45° field of view · 2352x1568px · CFP.
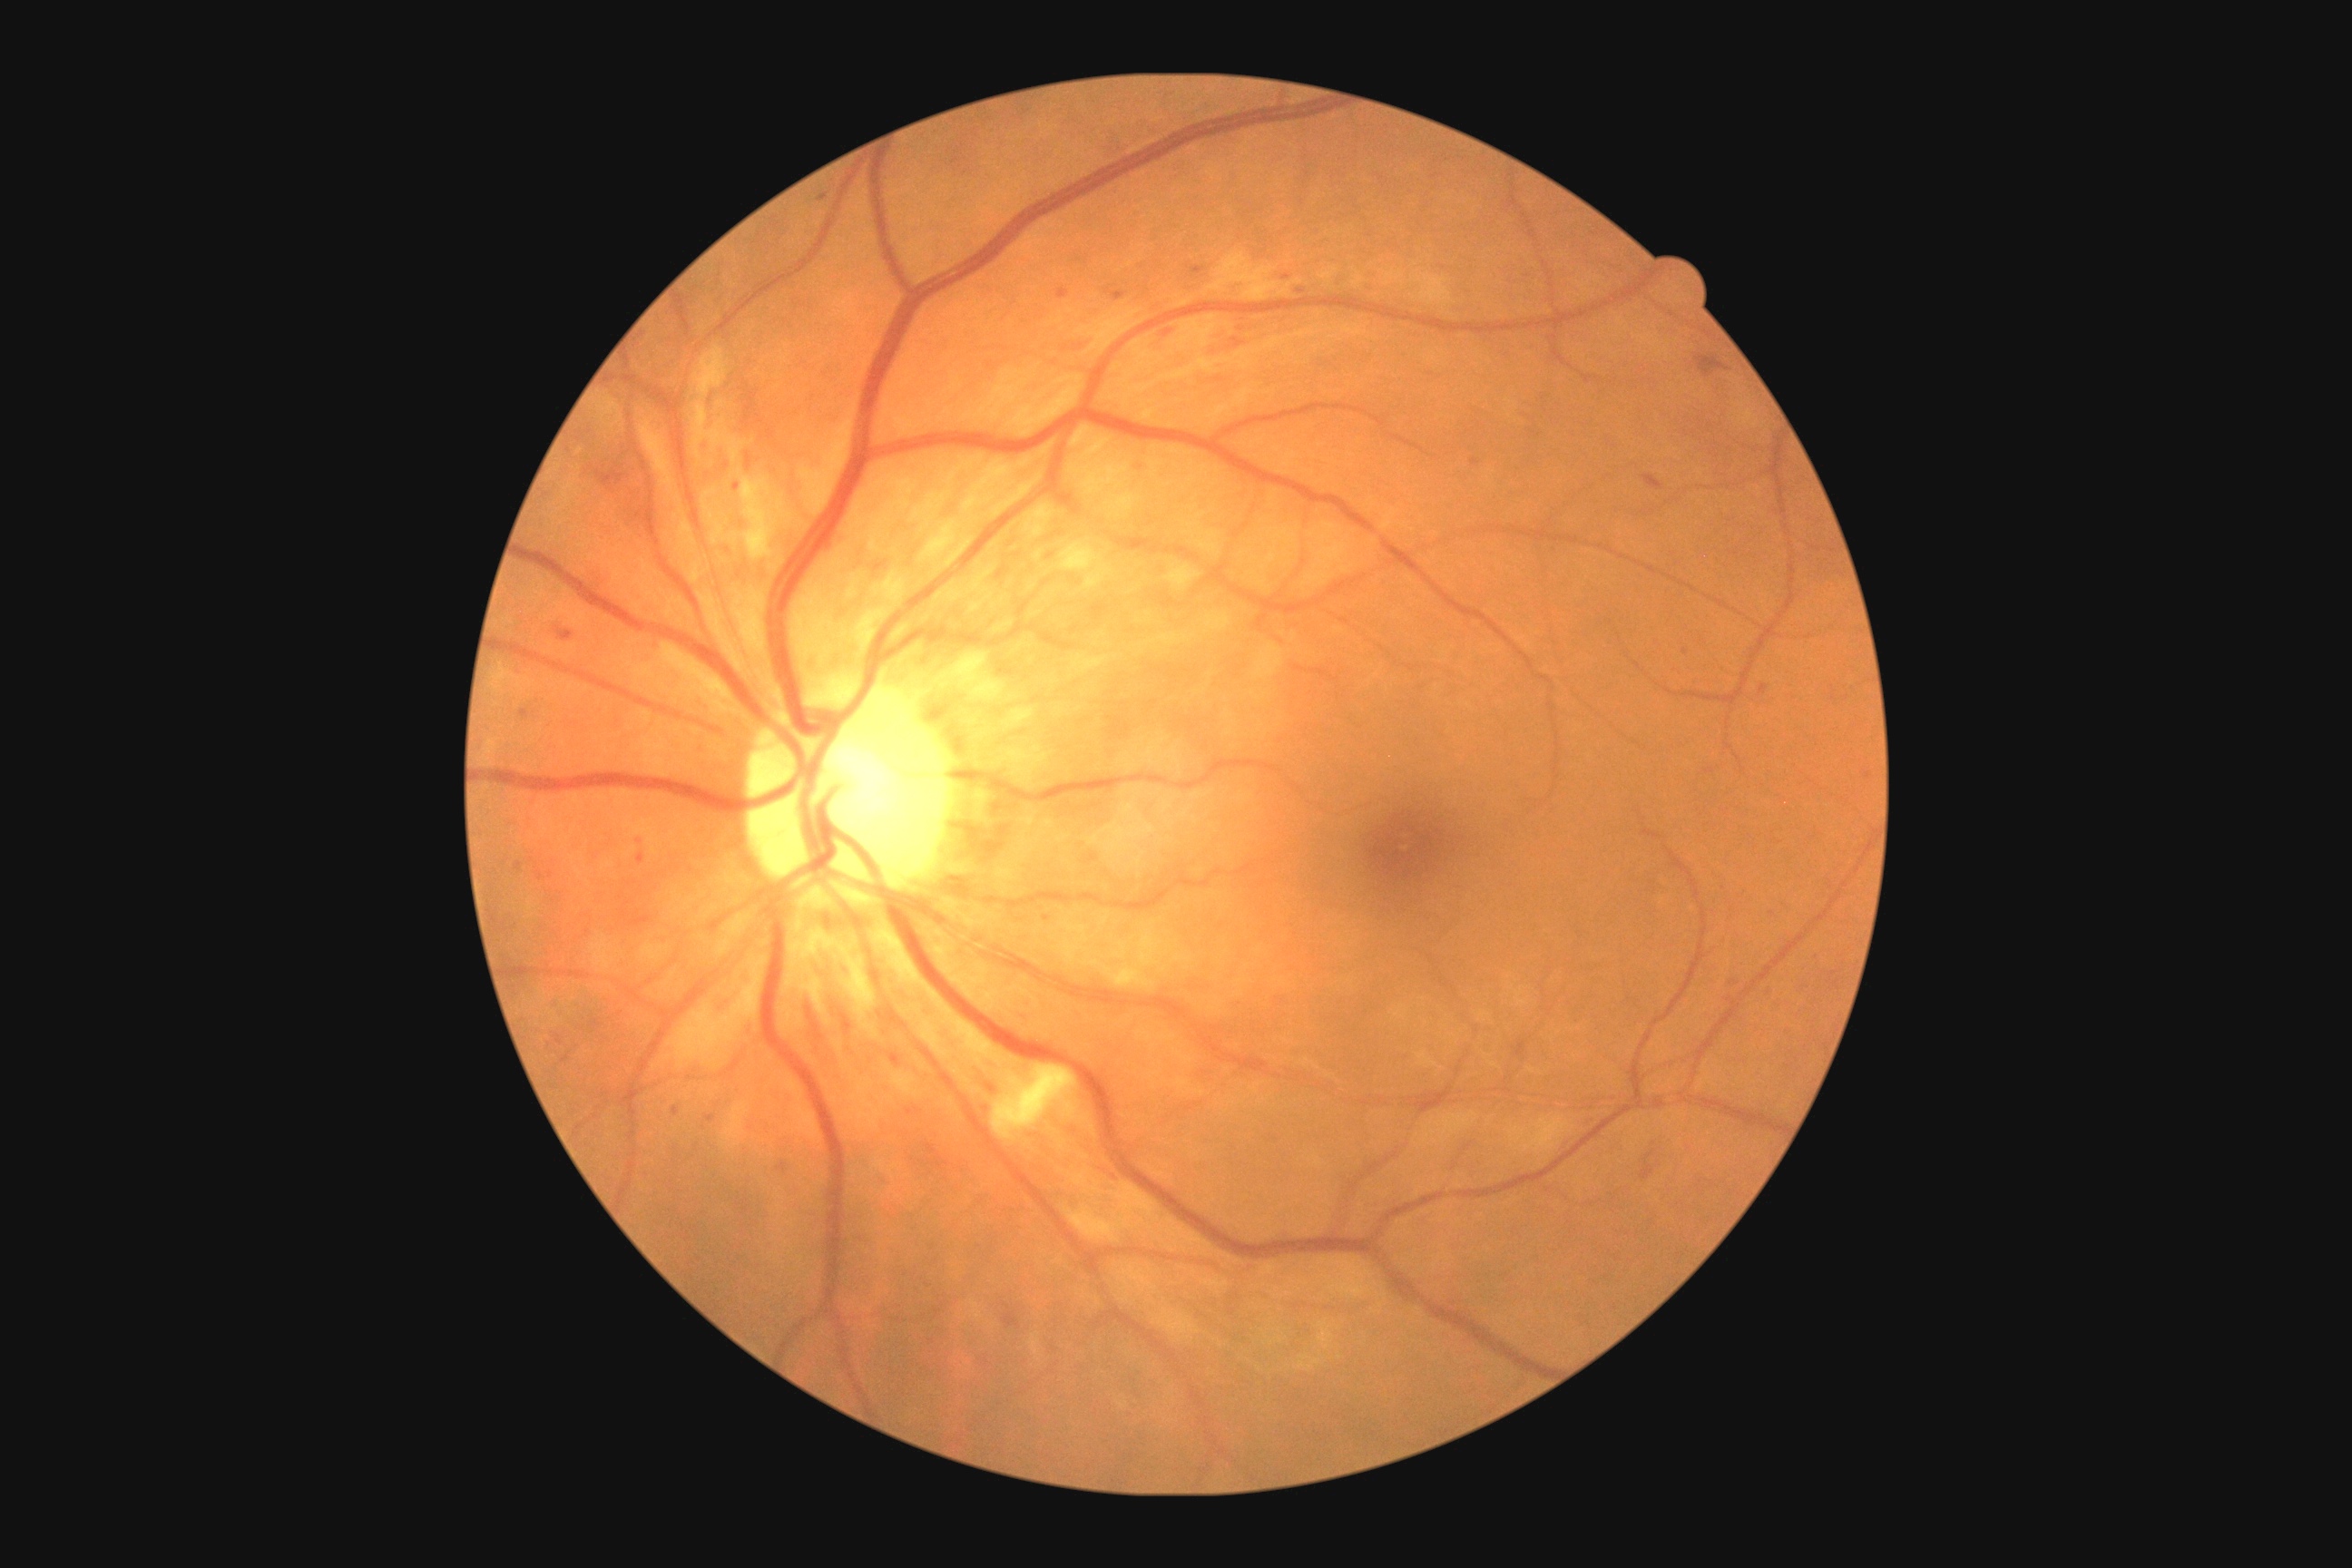

Retinopathy: moderate NPDR (grade 2).